Infant wide-field fundus photograph · image size 1440x1080:
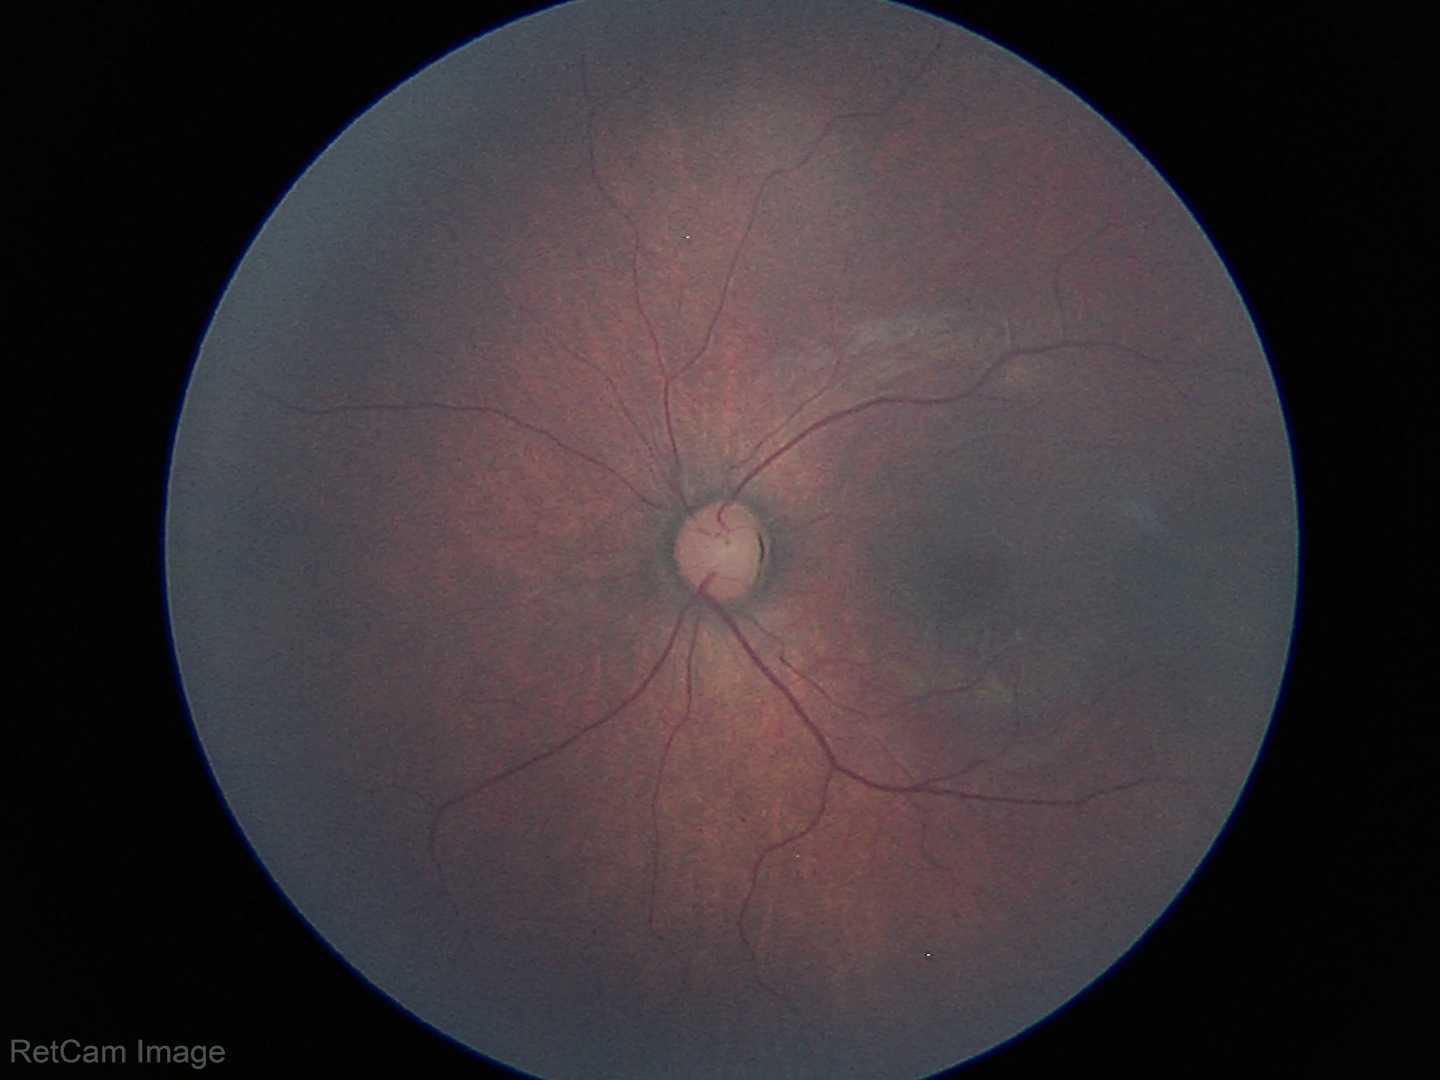

Physiological retinal appearance for postconceptual age.